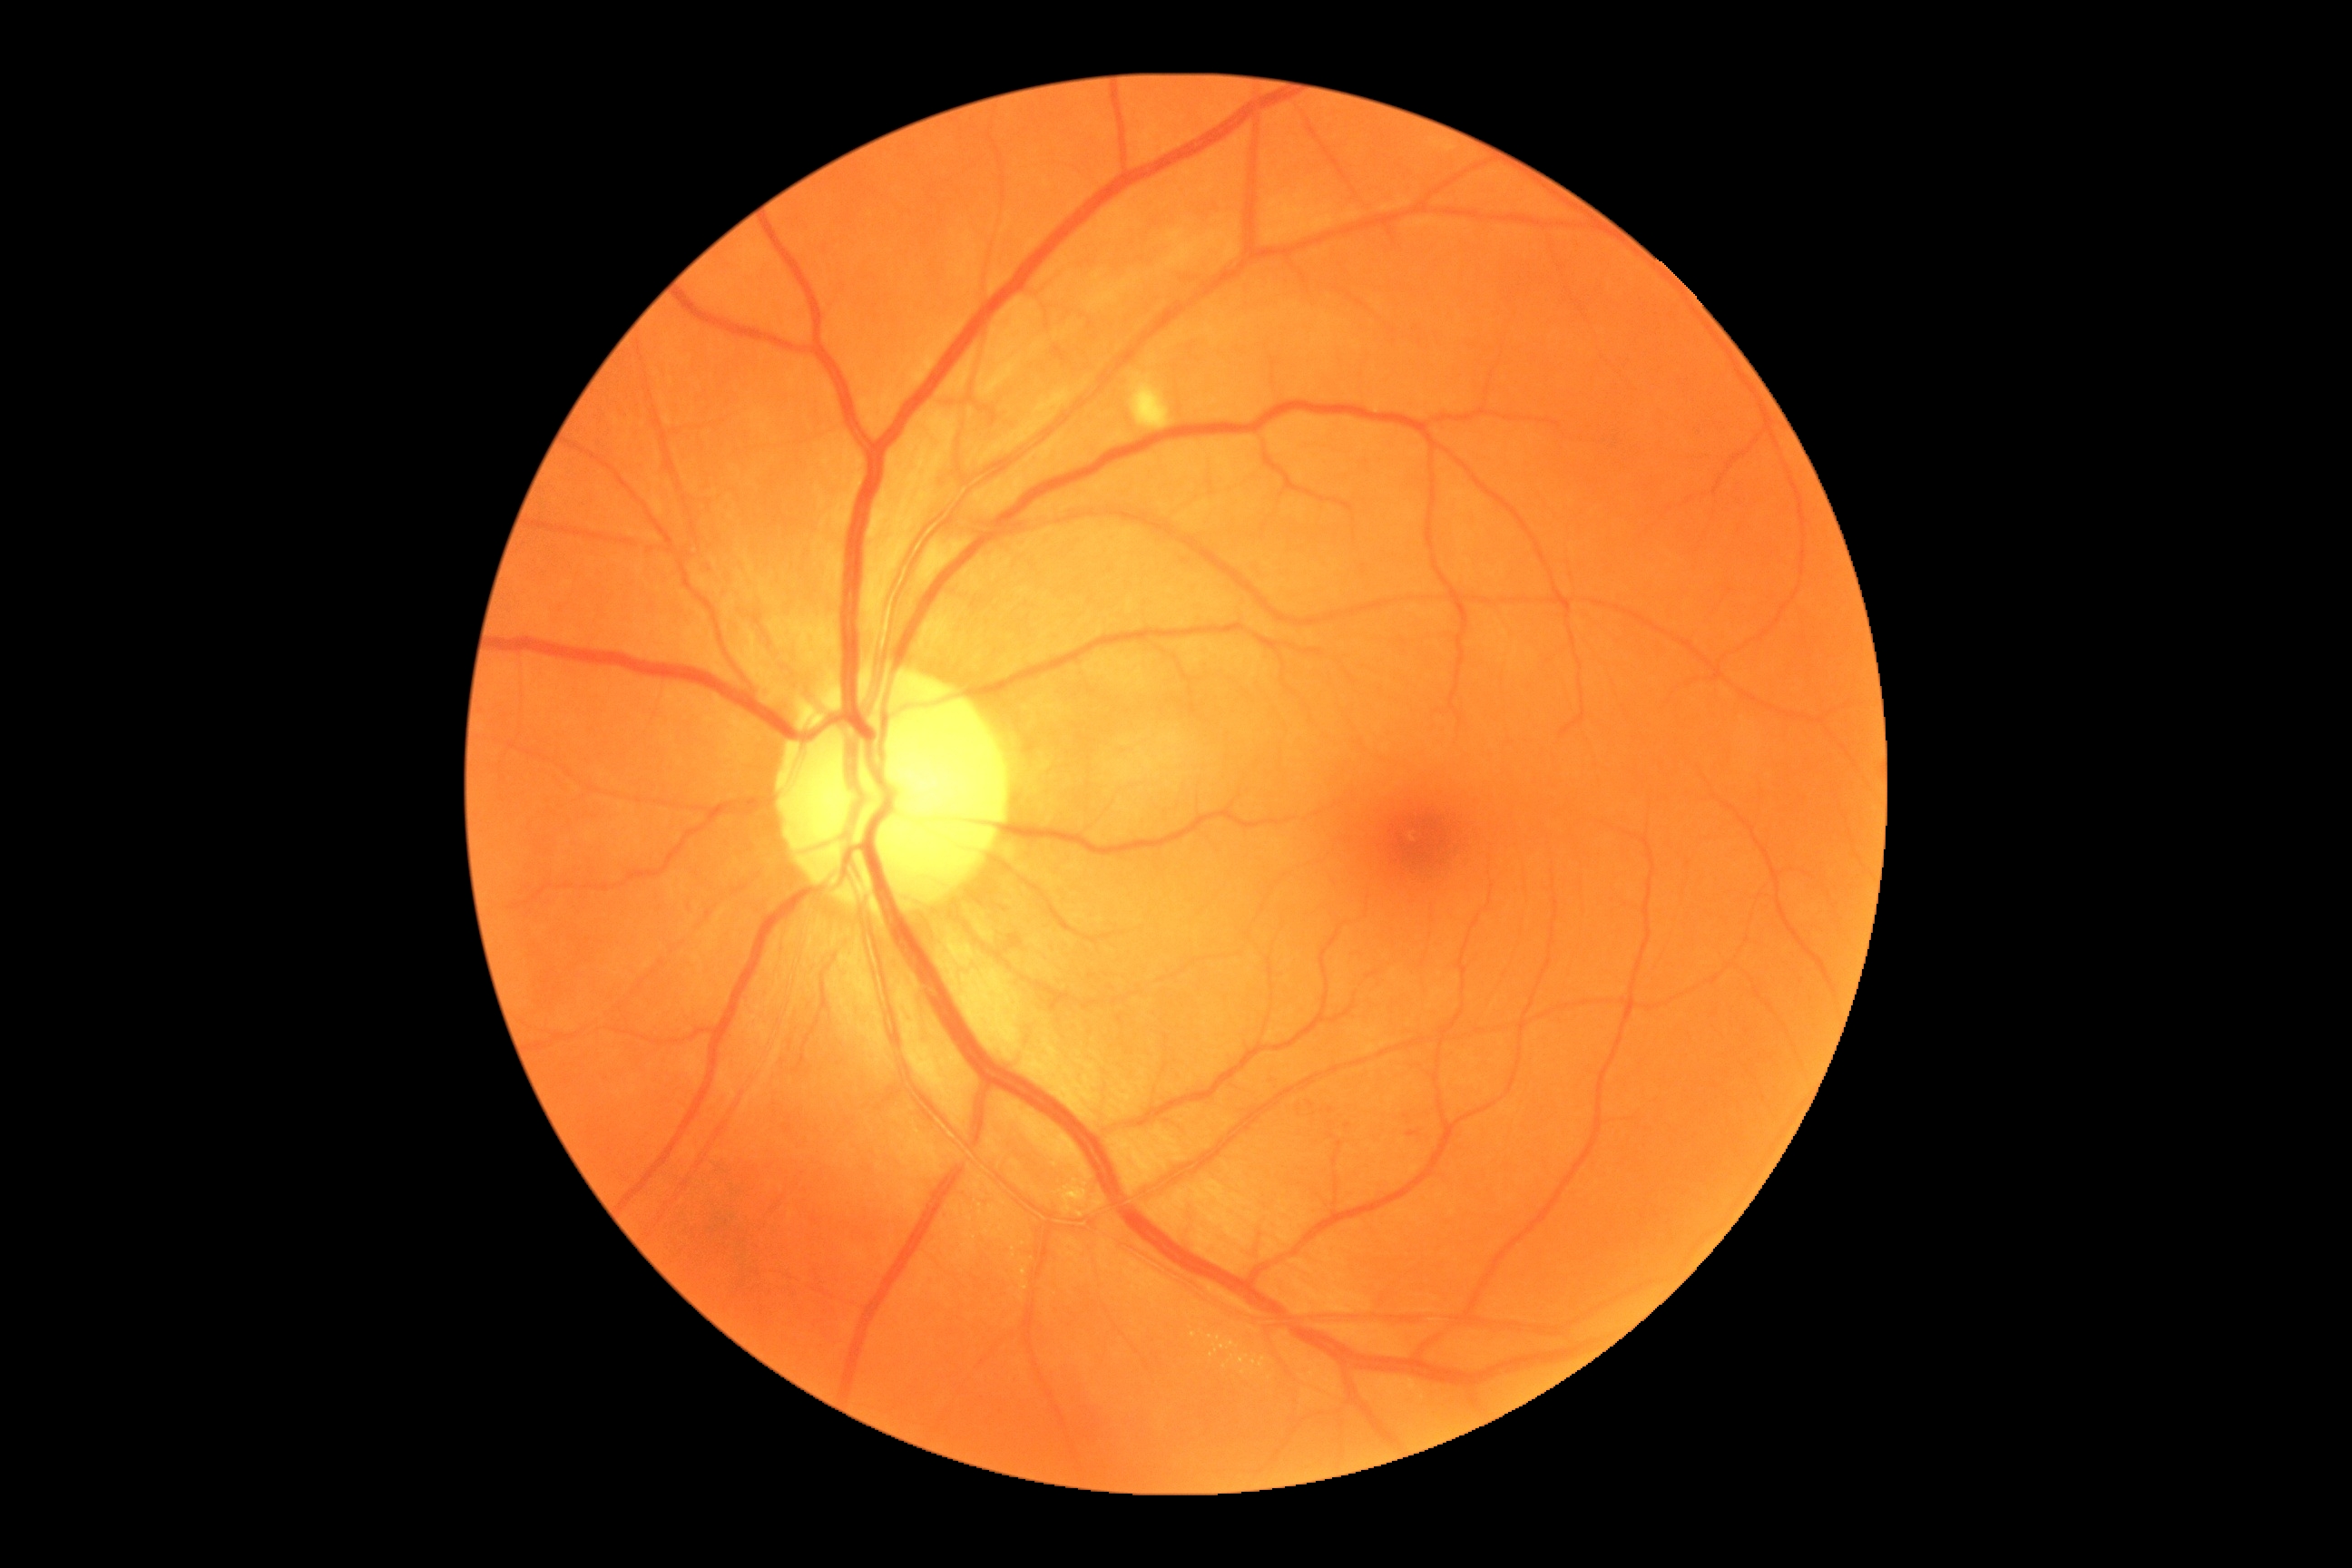

• DR class: non-proliferative diabetic retinopathy
• retinopathy grade: 2/4